Captured with the Clarity RetCam 3 (130° field of view). RetCam wide-field infant fundus image:
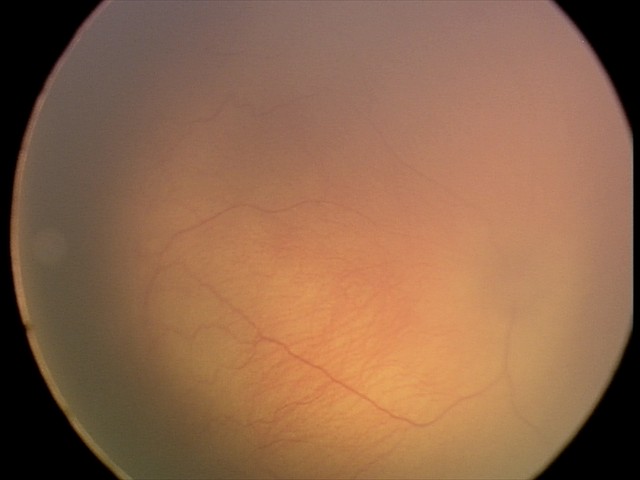

ROP grade = stage 0
plus form = absent — posterior pole vessels without abnormal dilation or tortuosity